Nonmydriatic; FOV: 45 degrees; DR severity per modified Davis staging.
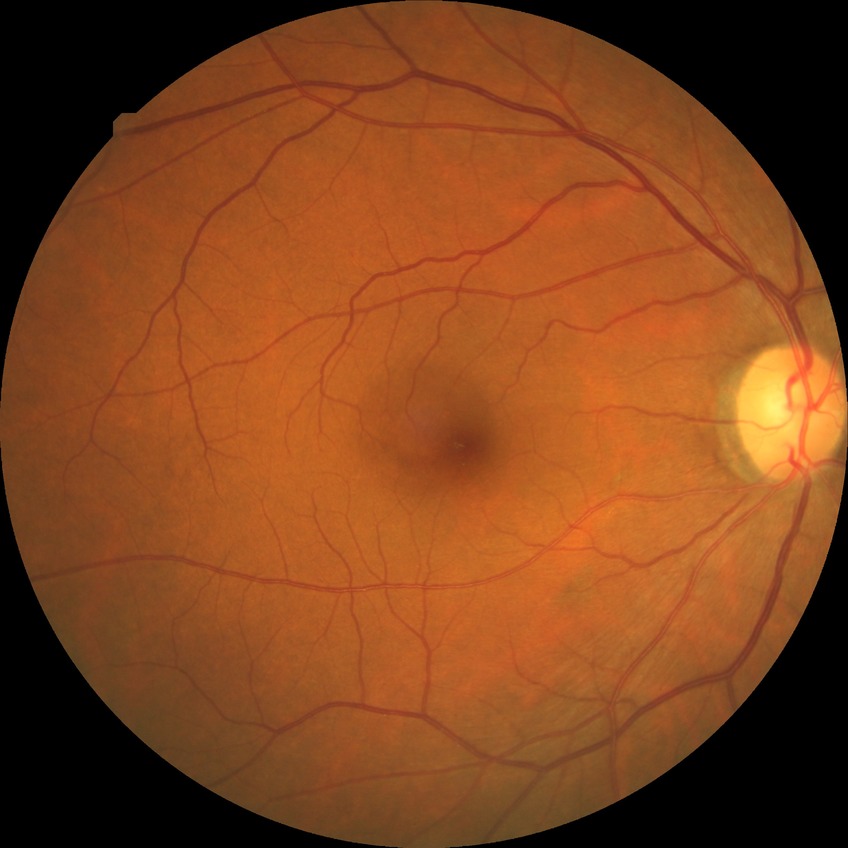

Retinopathy stage is no diabetic retinopathy.